130° field of view (Clarity RetCam 3). Infant wide-field fundus photograph:
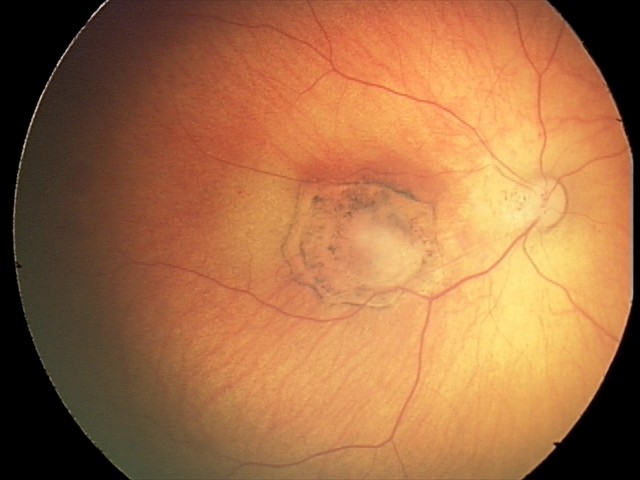
Examination diagnosed as toxoplasmosis chorioretinitis.